Tabletop color fundus camera image.
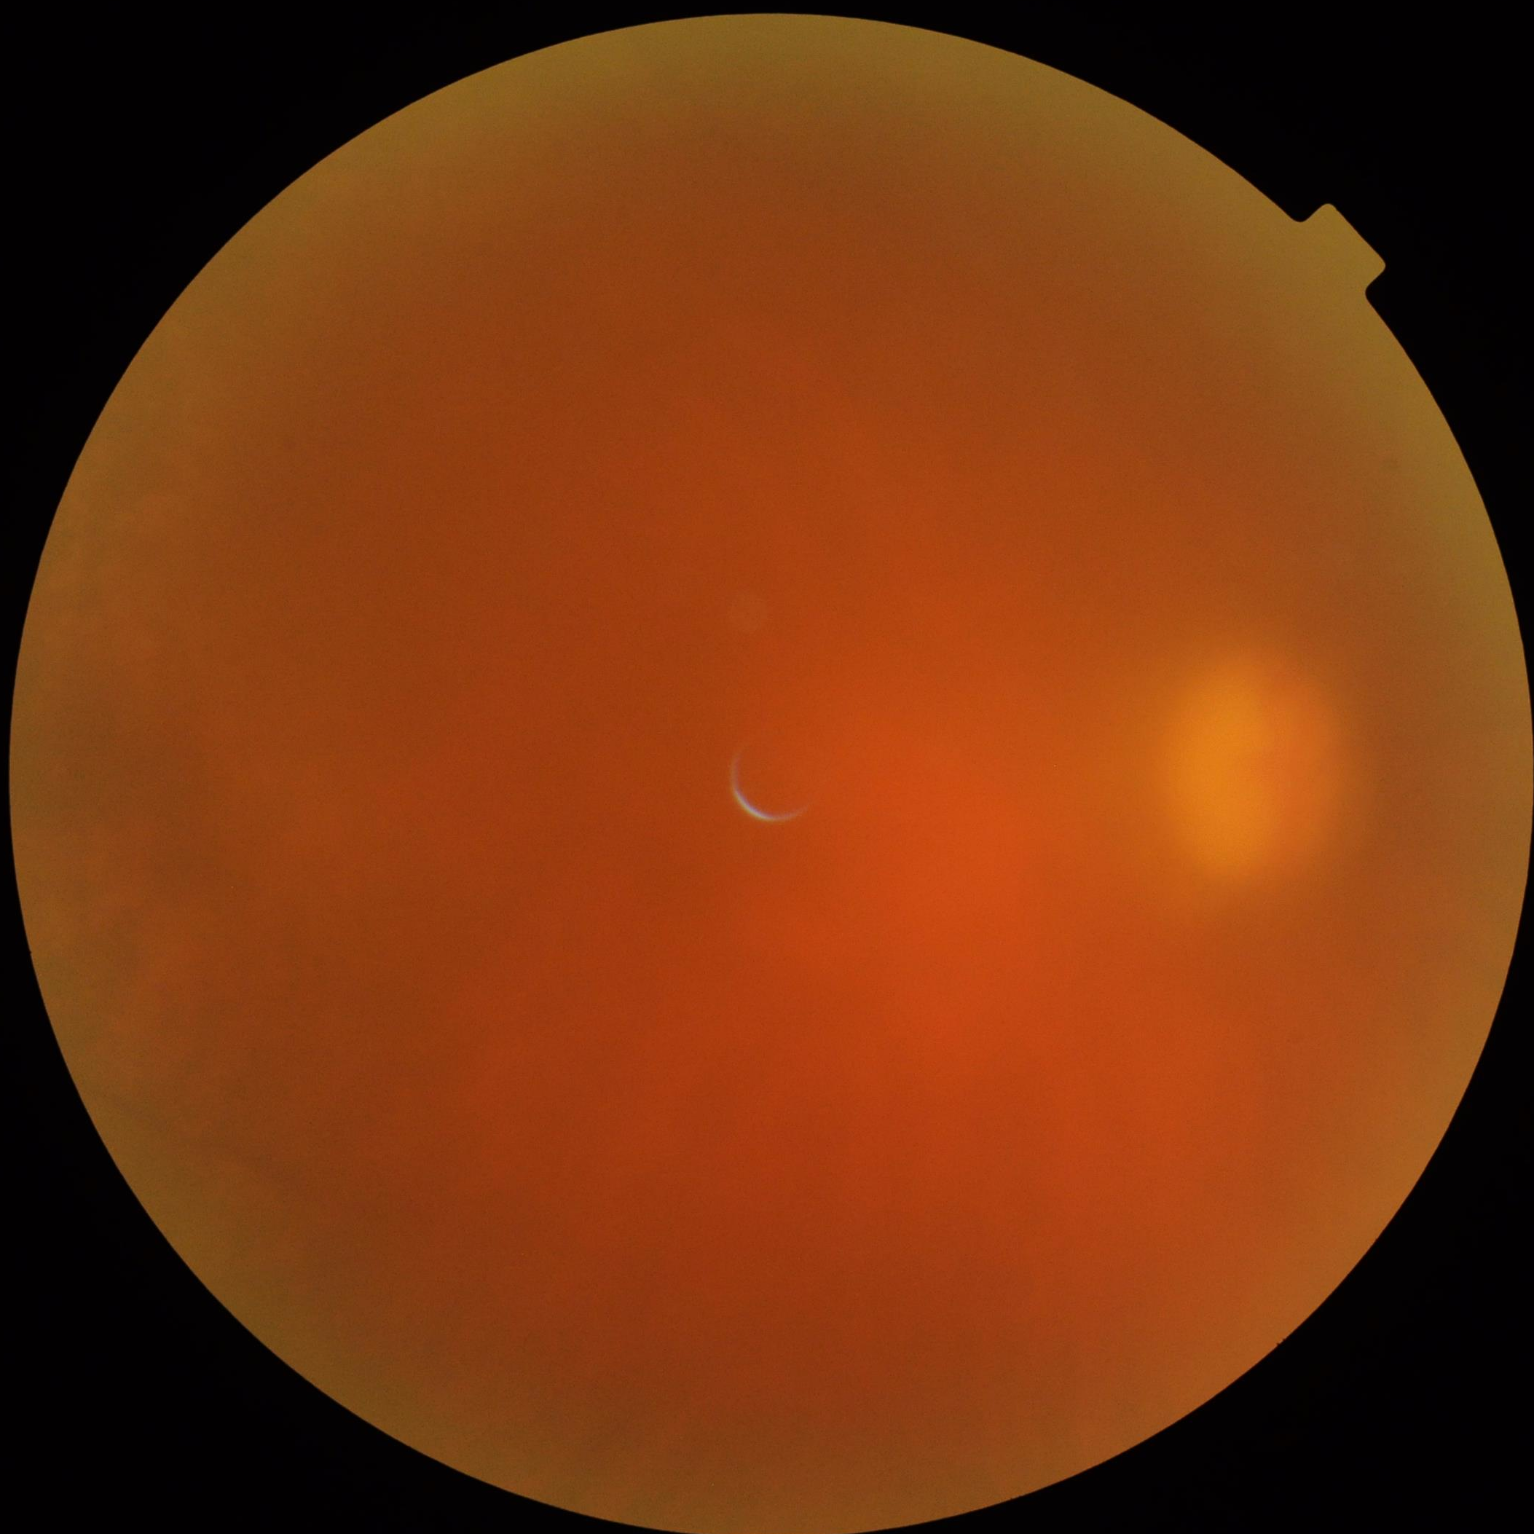

Contrast: low
Illumination/color: suboptimal
Focus: poor
Overall image quality: low